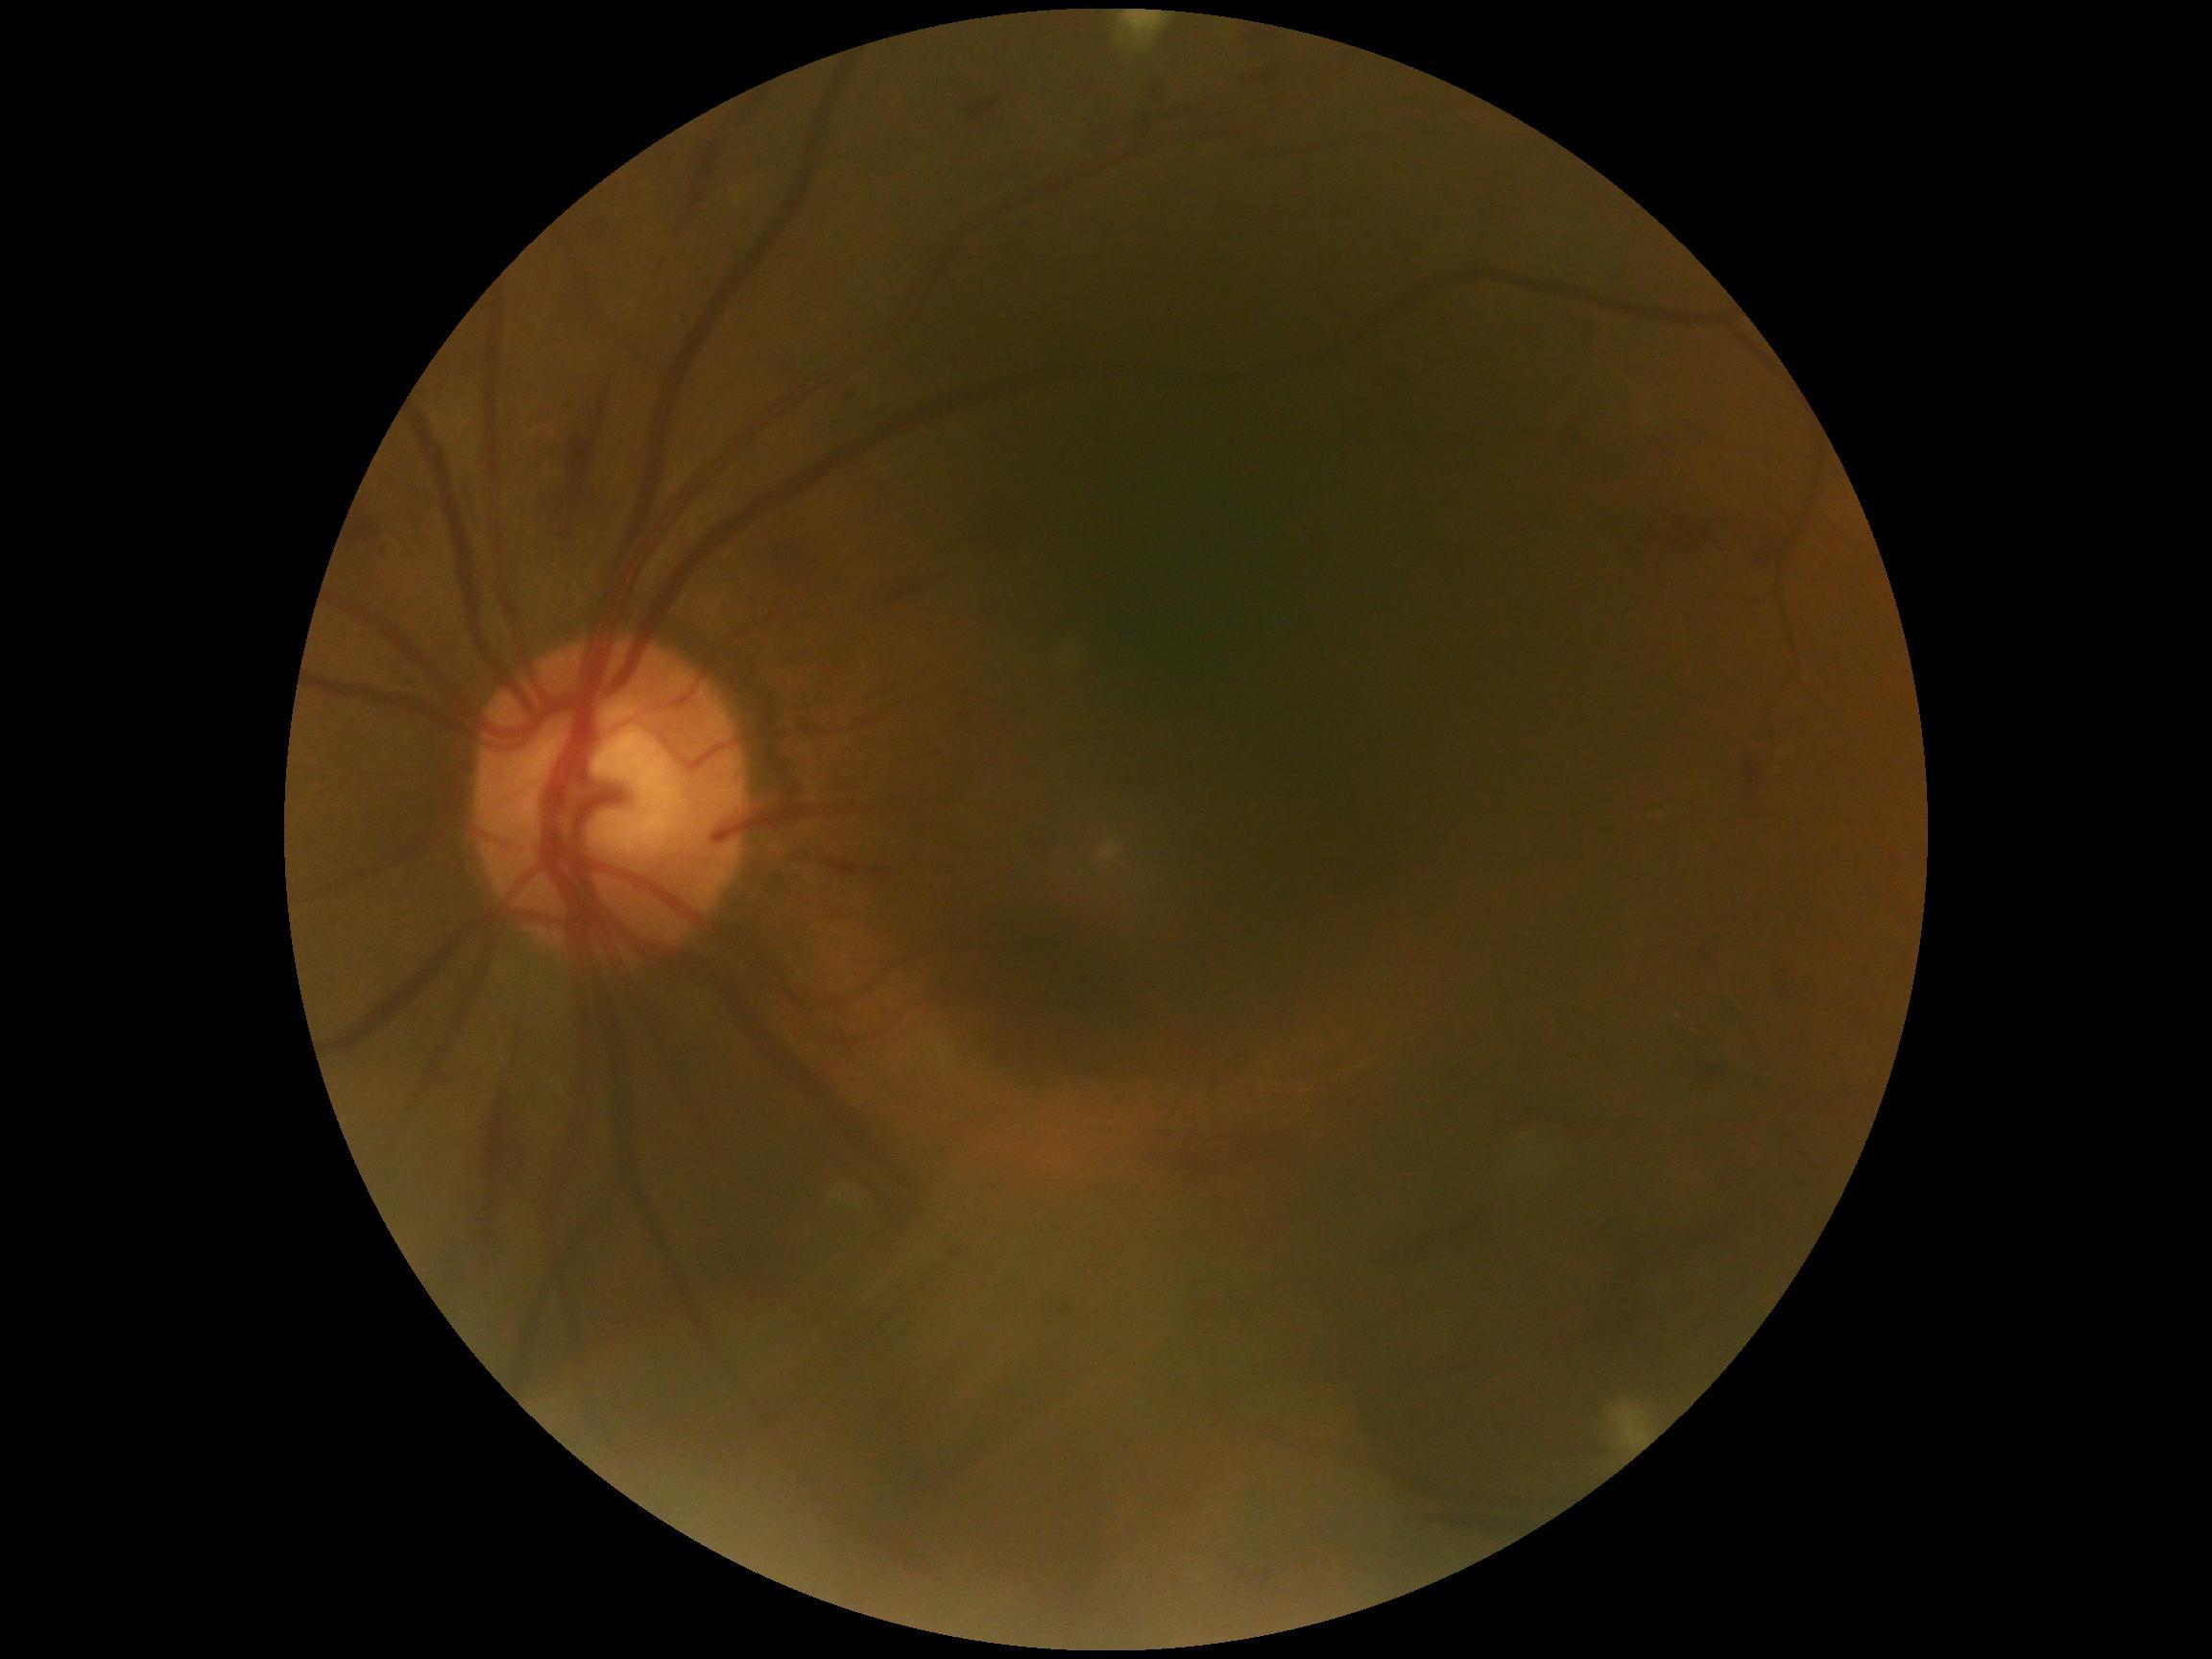
Disease class: non-proliferative diabetic retinopathy.
Diabetic retinopathy grade: 2.